Acquired with a Remidio Fundus on Phone (FOP) camera — 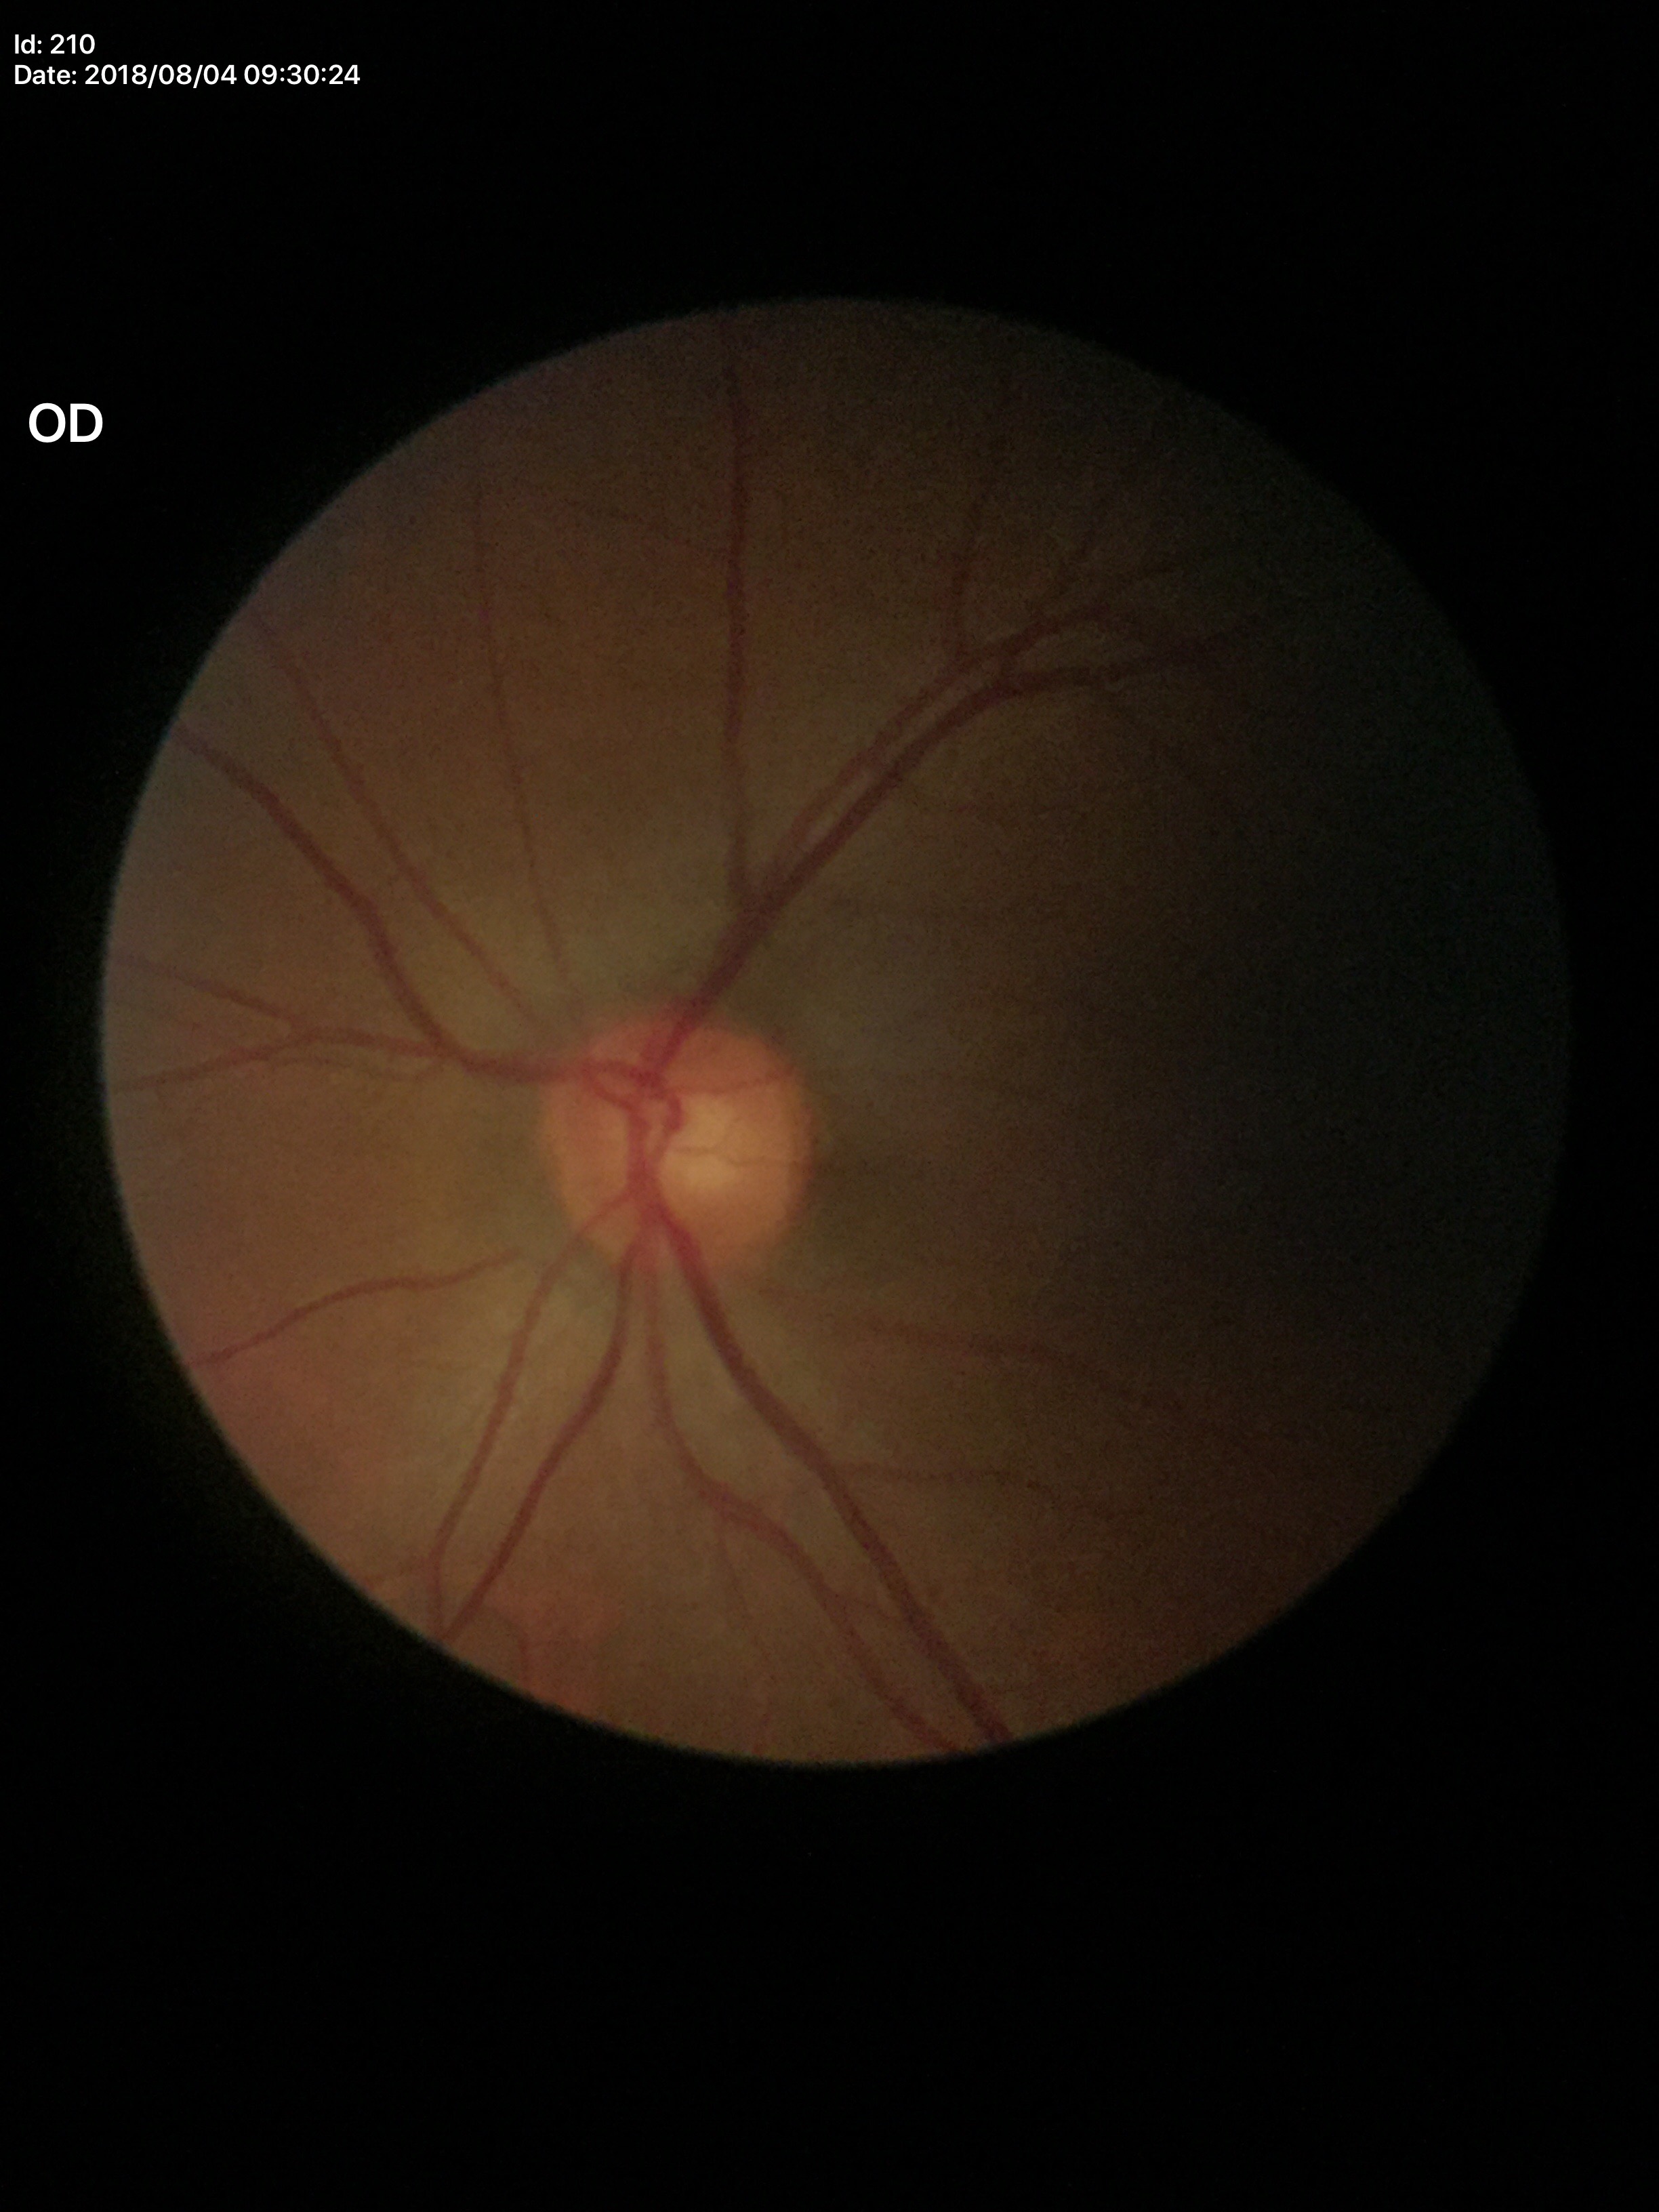
Glaucoma assessment: no suspicious findings.
Vertical C/D ratio (VCDR) is 0.56.
Horizontal cup-to-disc ratio (HCDR): 0.55.